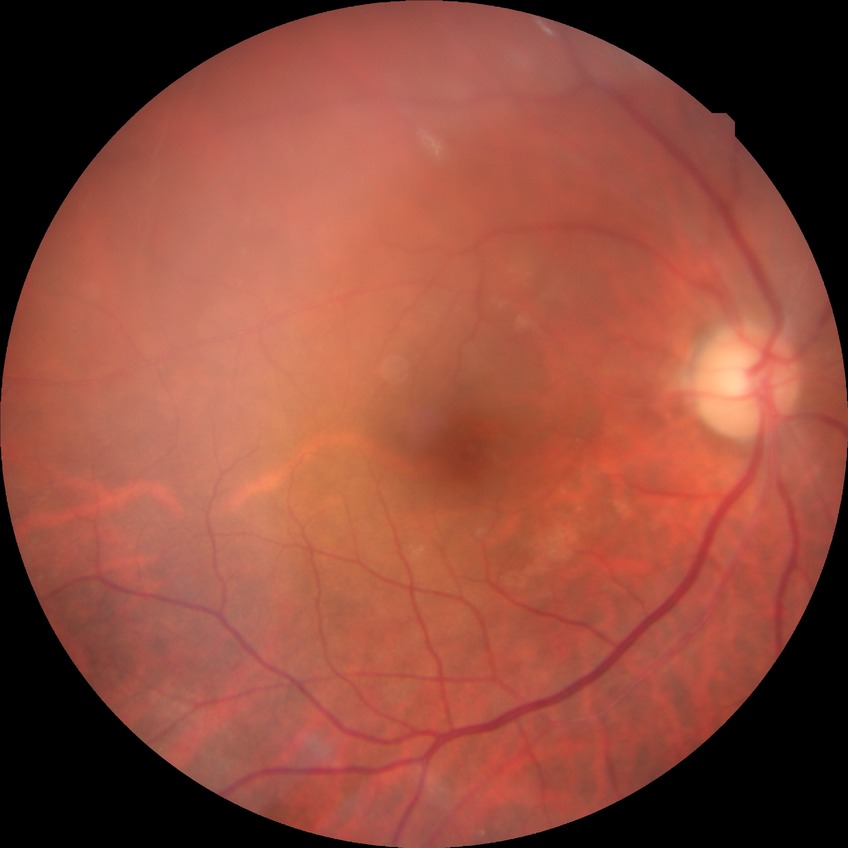

Diabetic retinopathy (DR): no diabetic retinopathy (NDR).